Mydriatic (tropicamide 0.5%) · color fundus photograph · macula at the center of the field
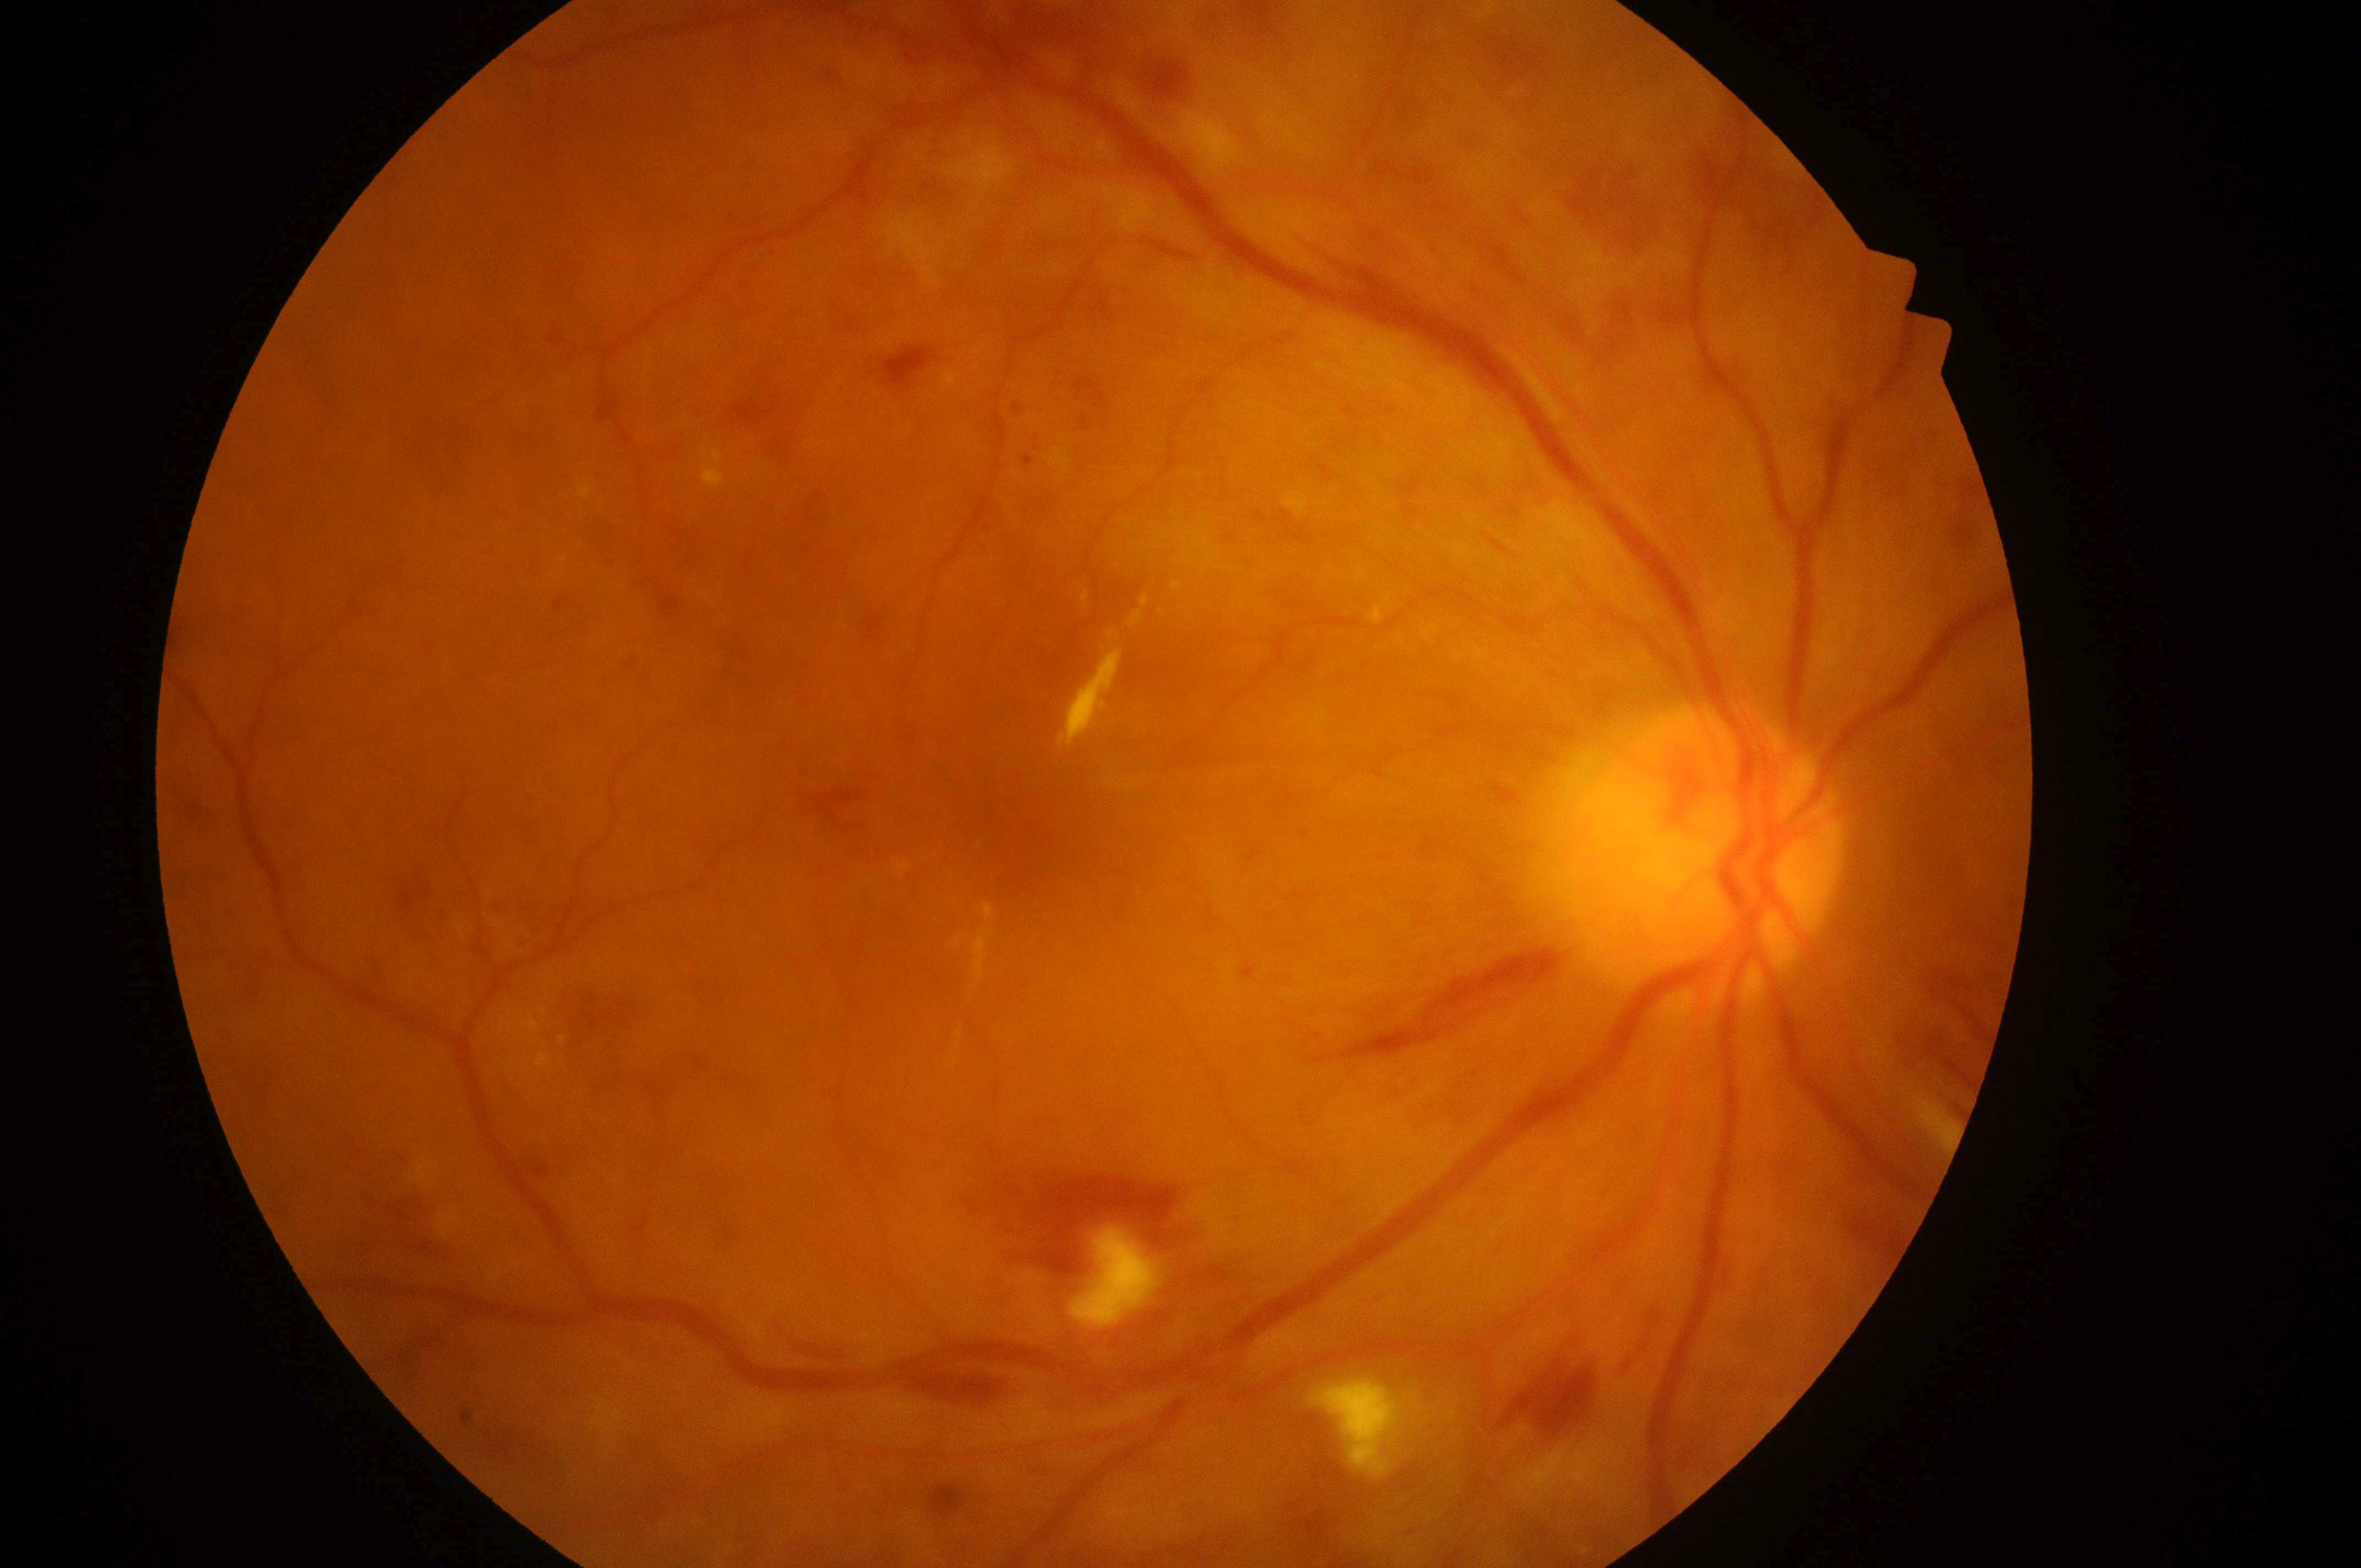
{
  "eye": "oculus dexter",
  "dme_grade": "2 (high risk)",
  "dr_grade": "severe non-proliferative diabetic retinopathy (grade 3)",
  "fovea": "[1017, 837]",
  "dr_category": "non-proliferative diabetic retinopathy",
  "optic_disc": "[1687, 858]"
}